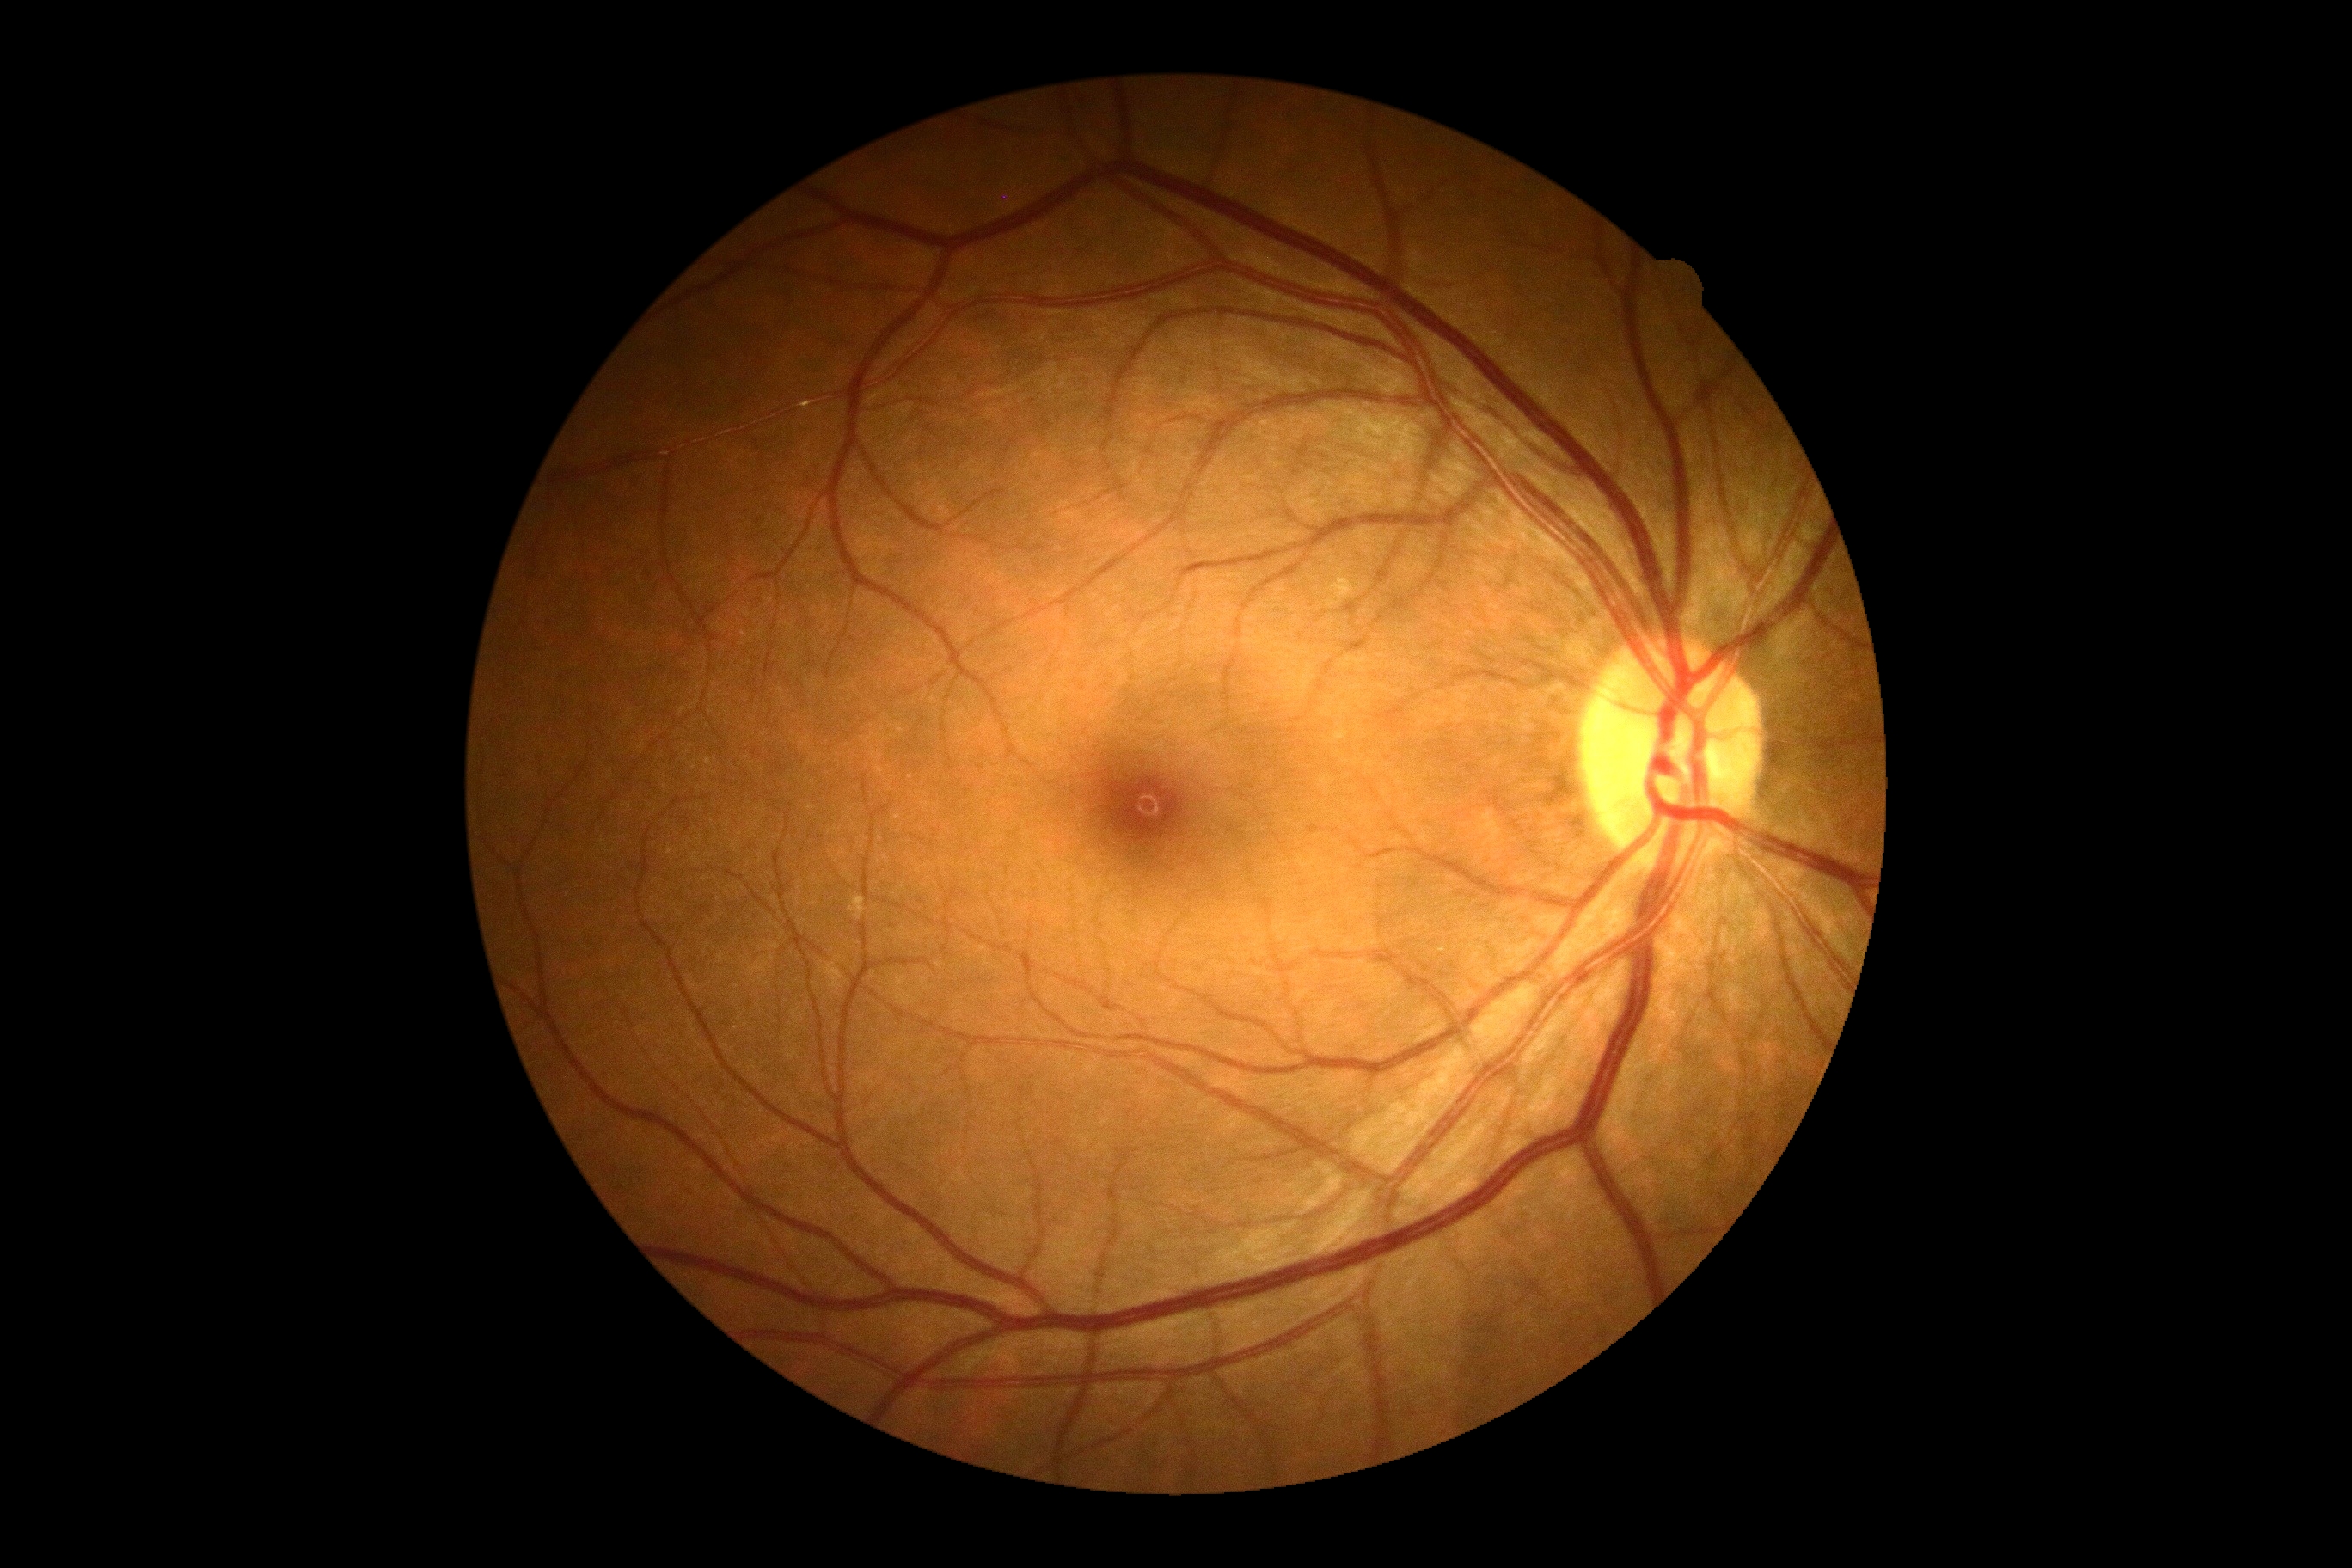

{
  "dr_grade": "no apparent diabetic retinopathy (grade 0) — no visible signs of diabetic retinopathy",
  "dr_impression": "no DR findings"
}